Gender: F · captured on a Topcon TRC-NW400 fundus camera · non-mydriatic acquisition · central corneal thickness 535 µm: 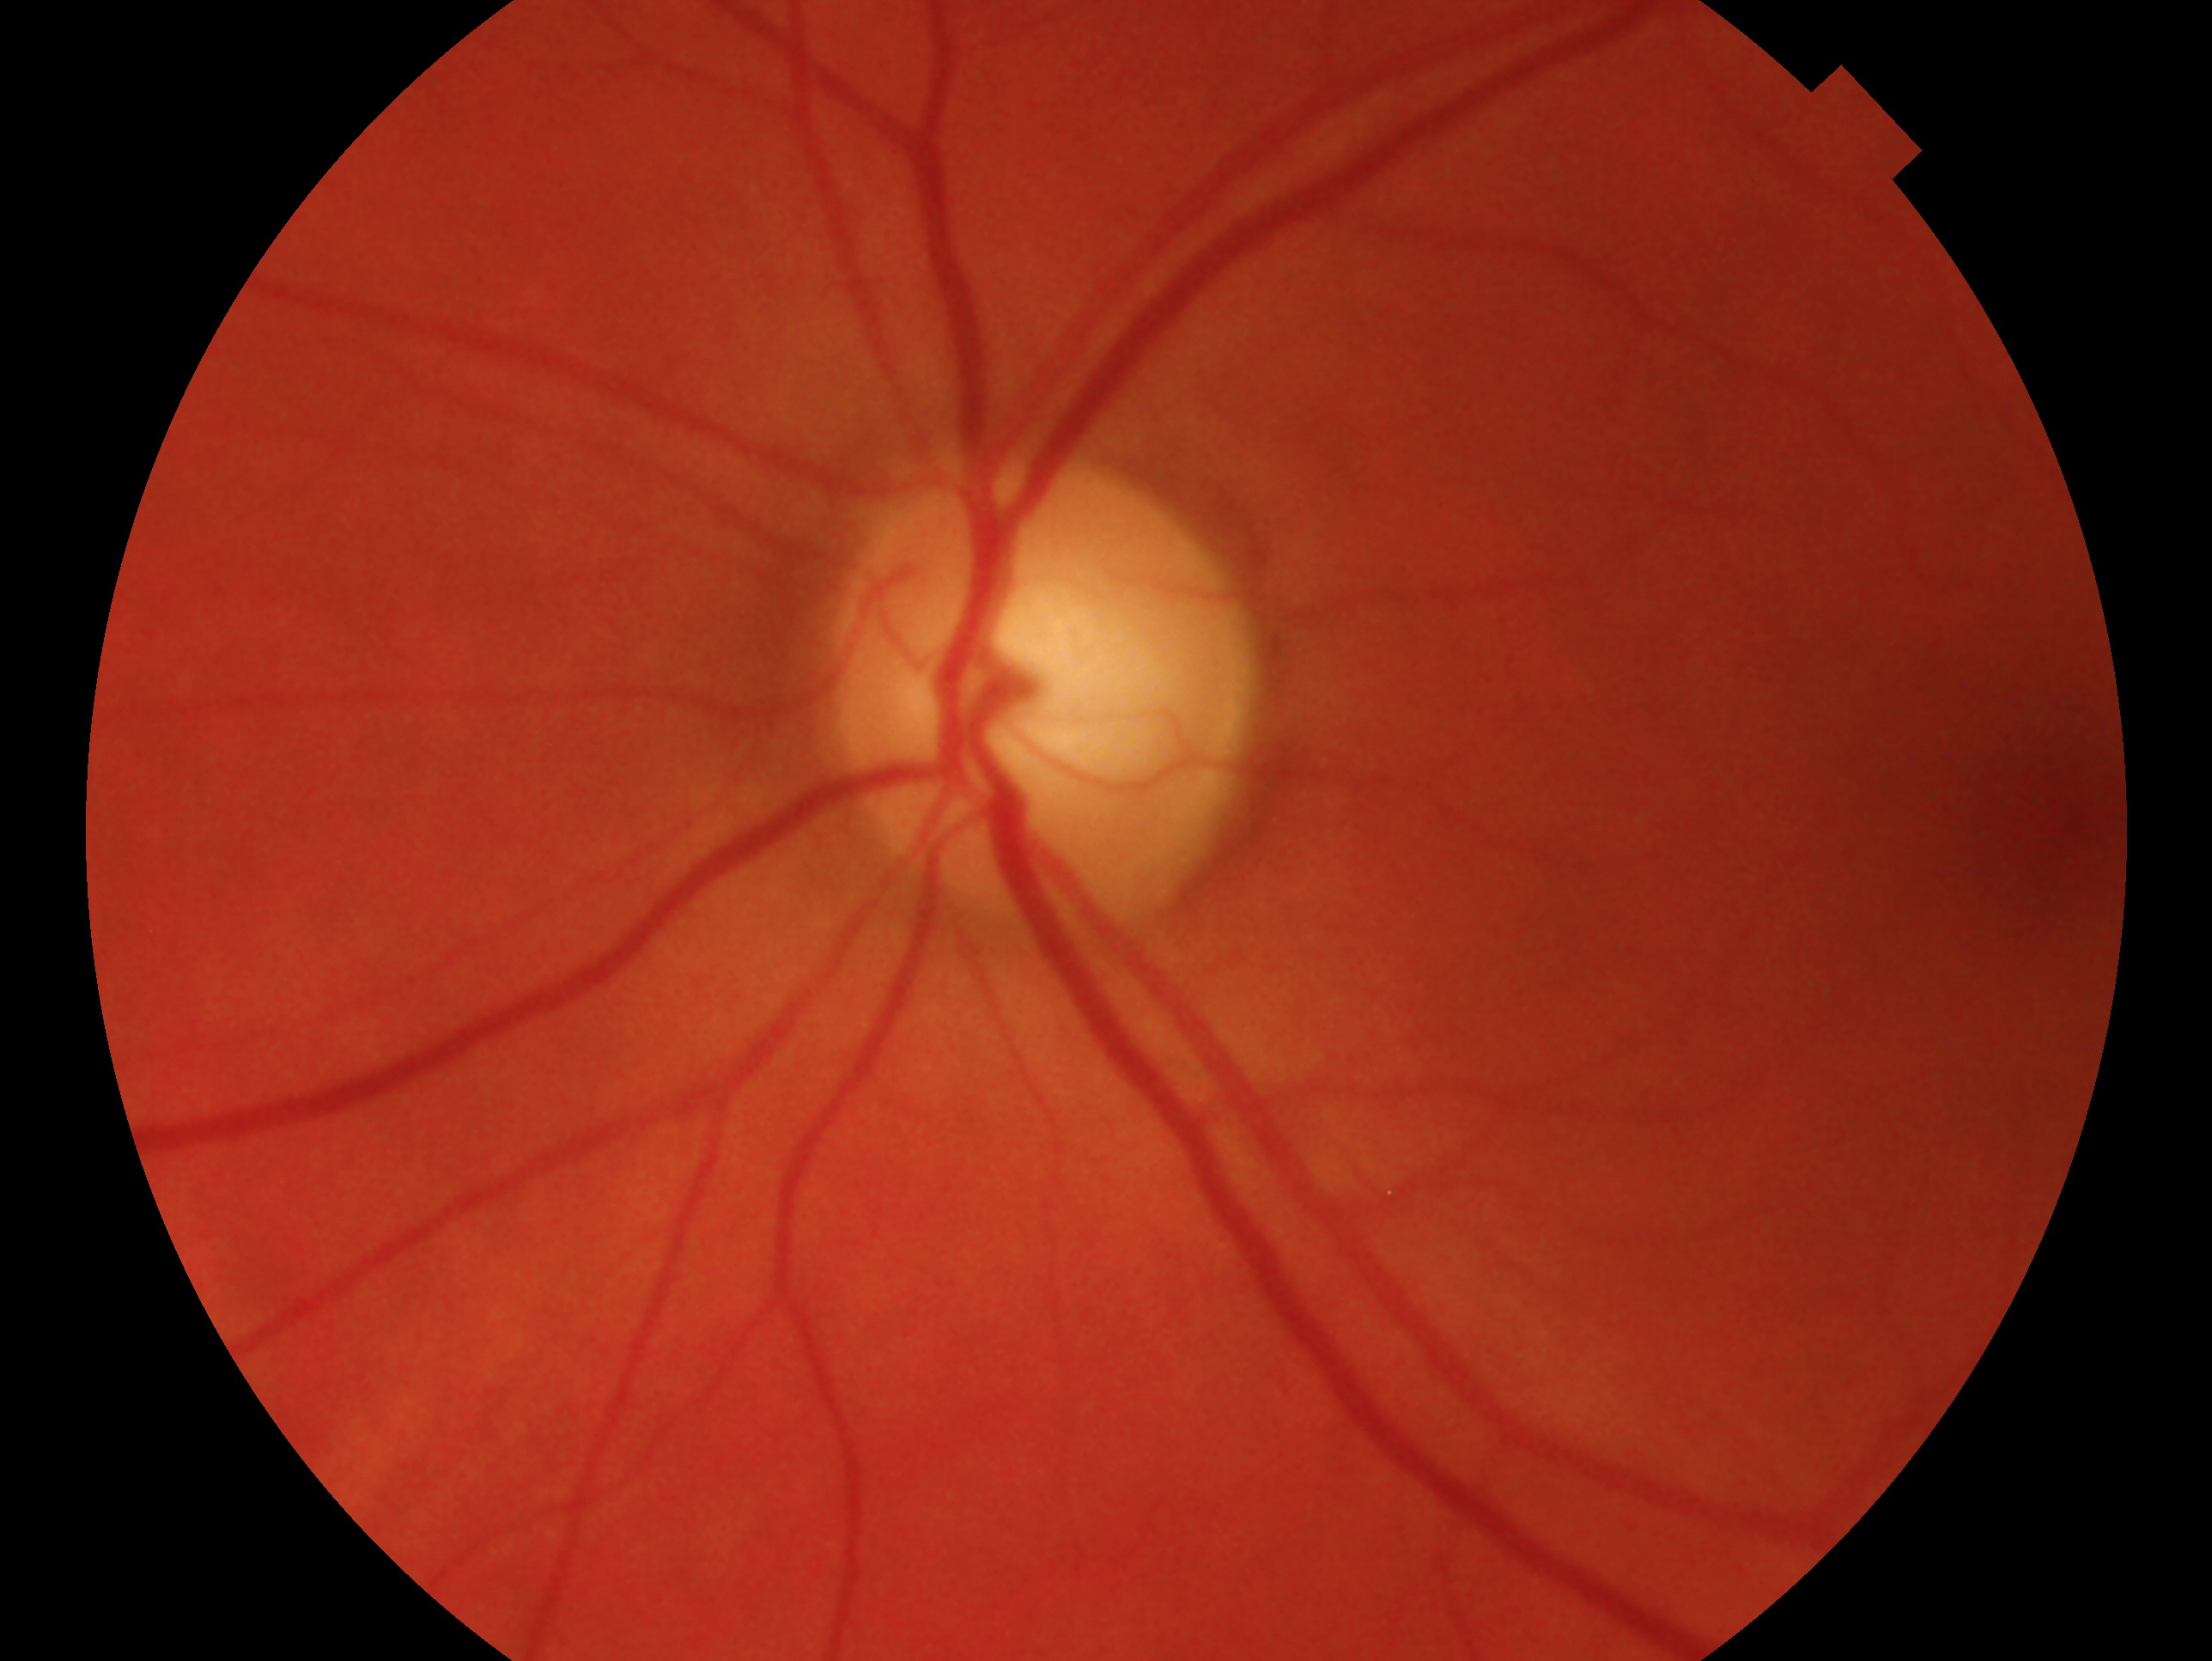 This is the oculus sinister. Assessment: no evidence of glaucoma — no clinical evidence of glaucoma in this eye.